Modified Davis classification; 848x848px.
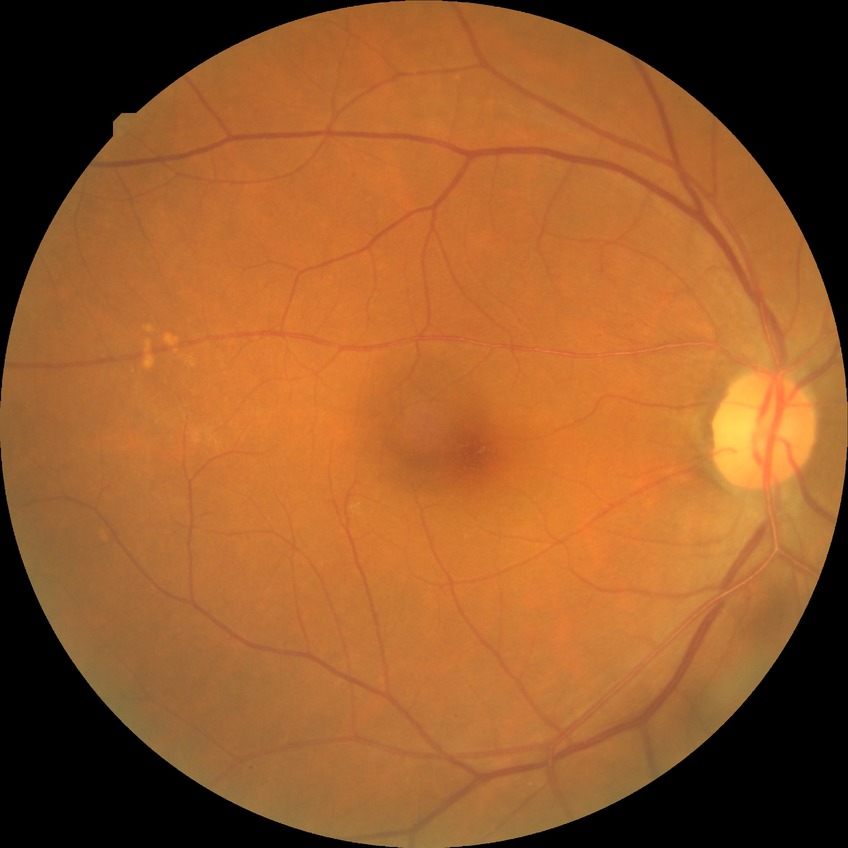 Diabetic retinopathy (DR): simple diabetic retinopathy (SDR).